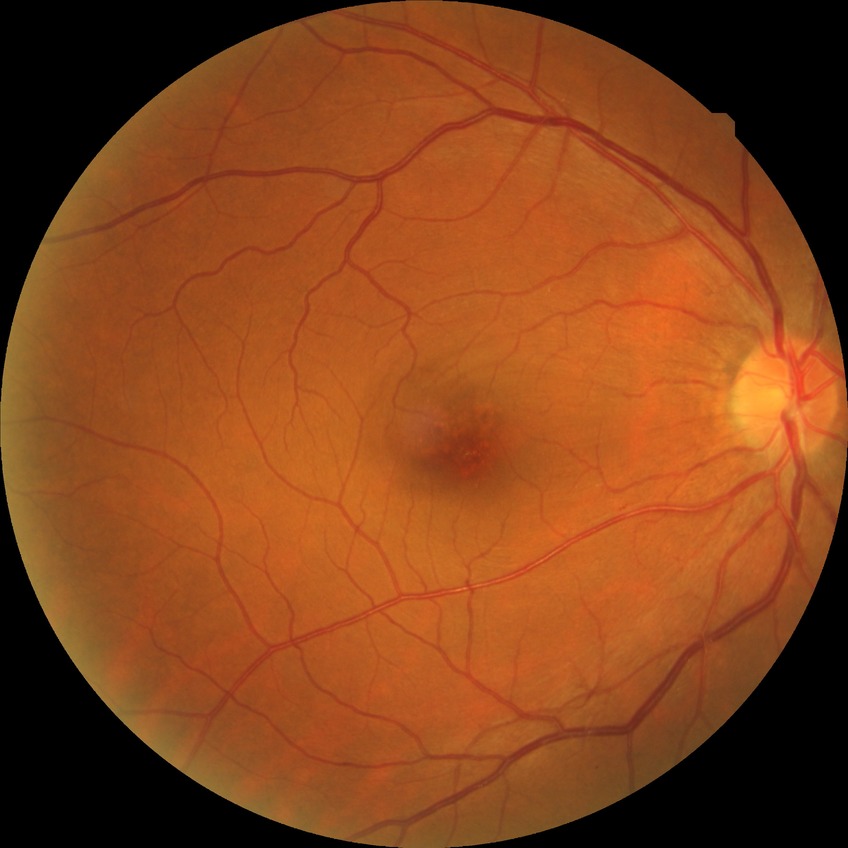 Diabetic retinopathy (DR) is no diabetic retinopathy (NDR).